Fundus photo.
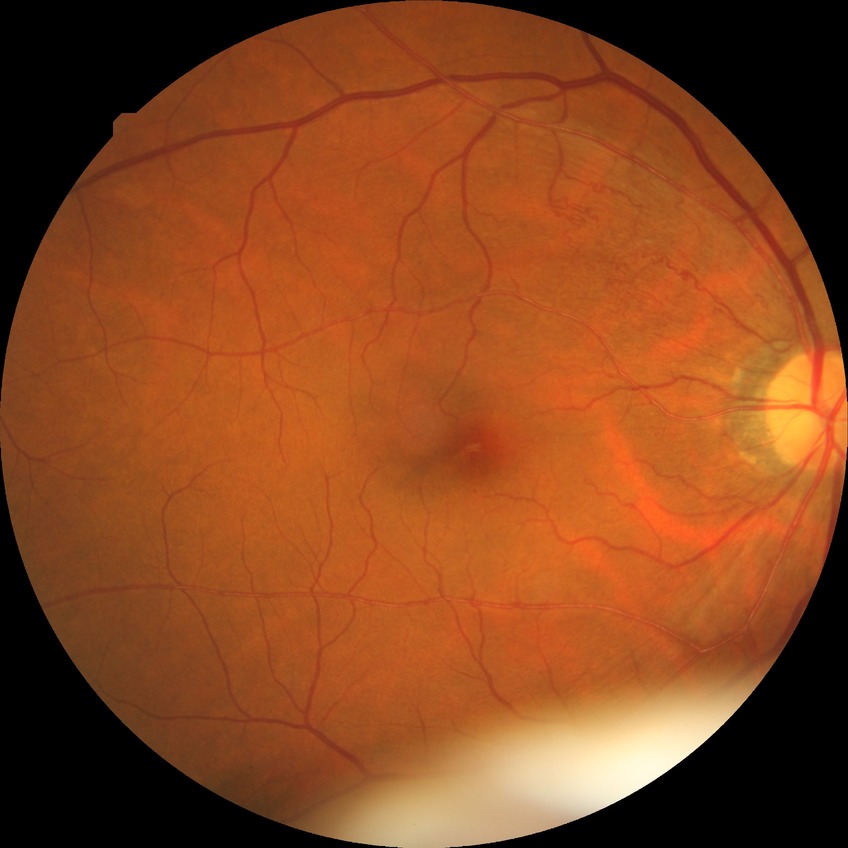 Modified Davis classification is no diabetic retinopathy.